Color fundus photograph; 2352x1568px; FOV: 45 degrees: 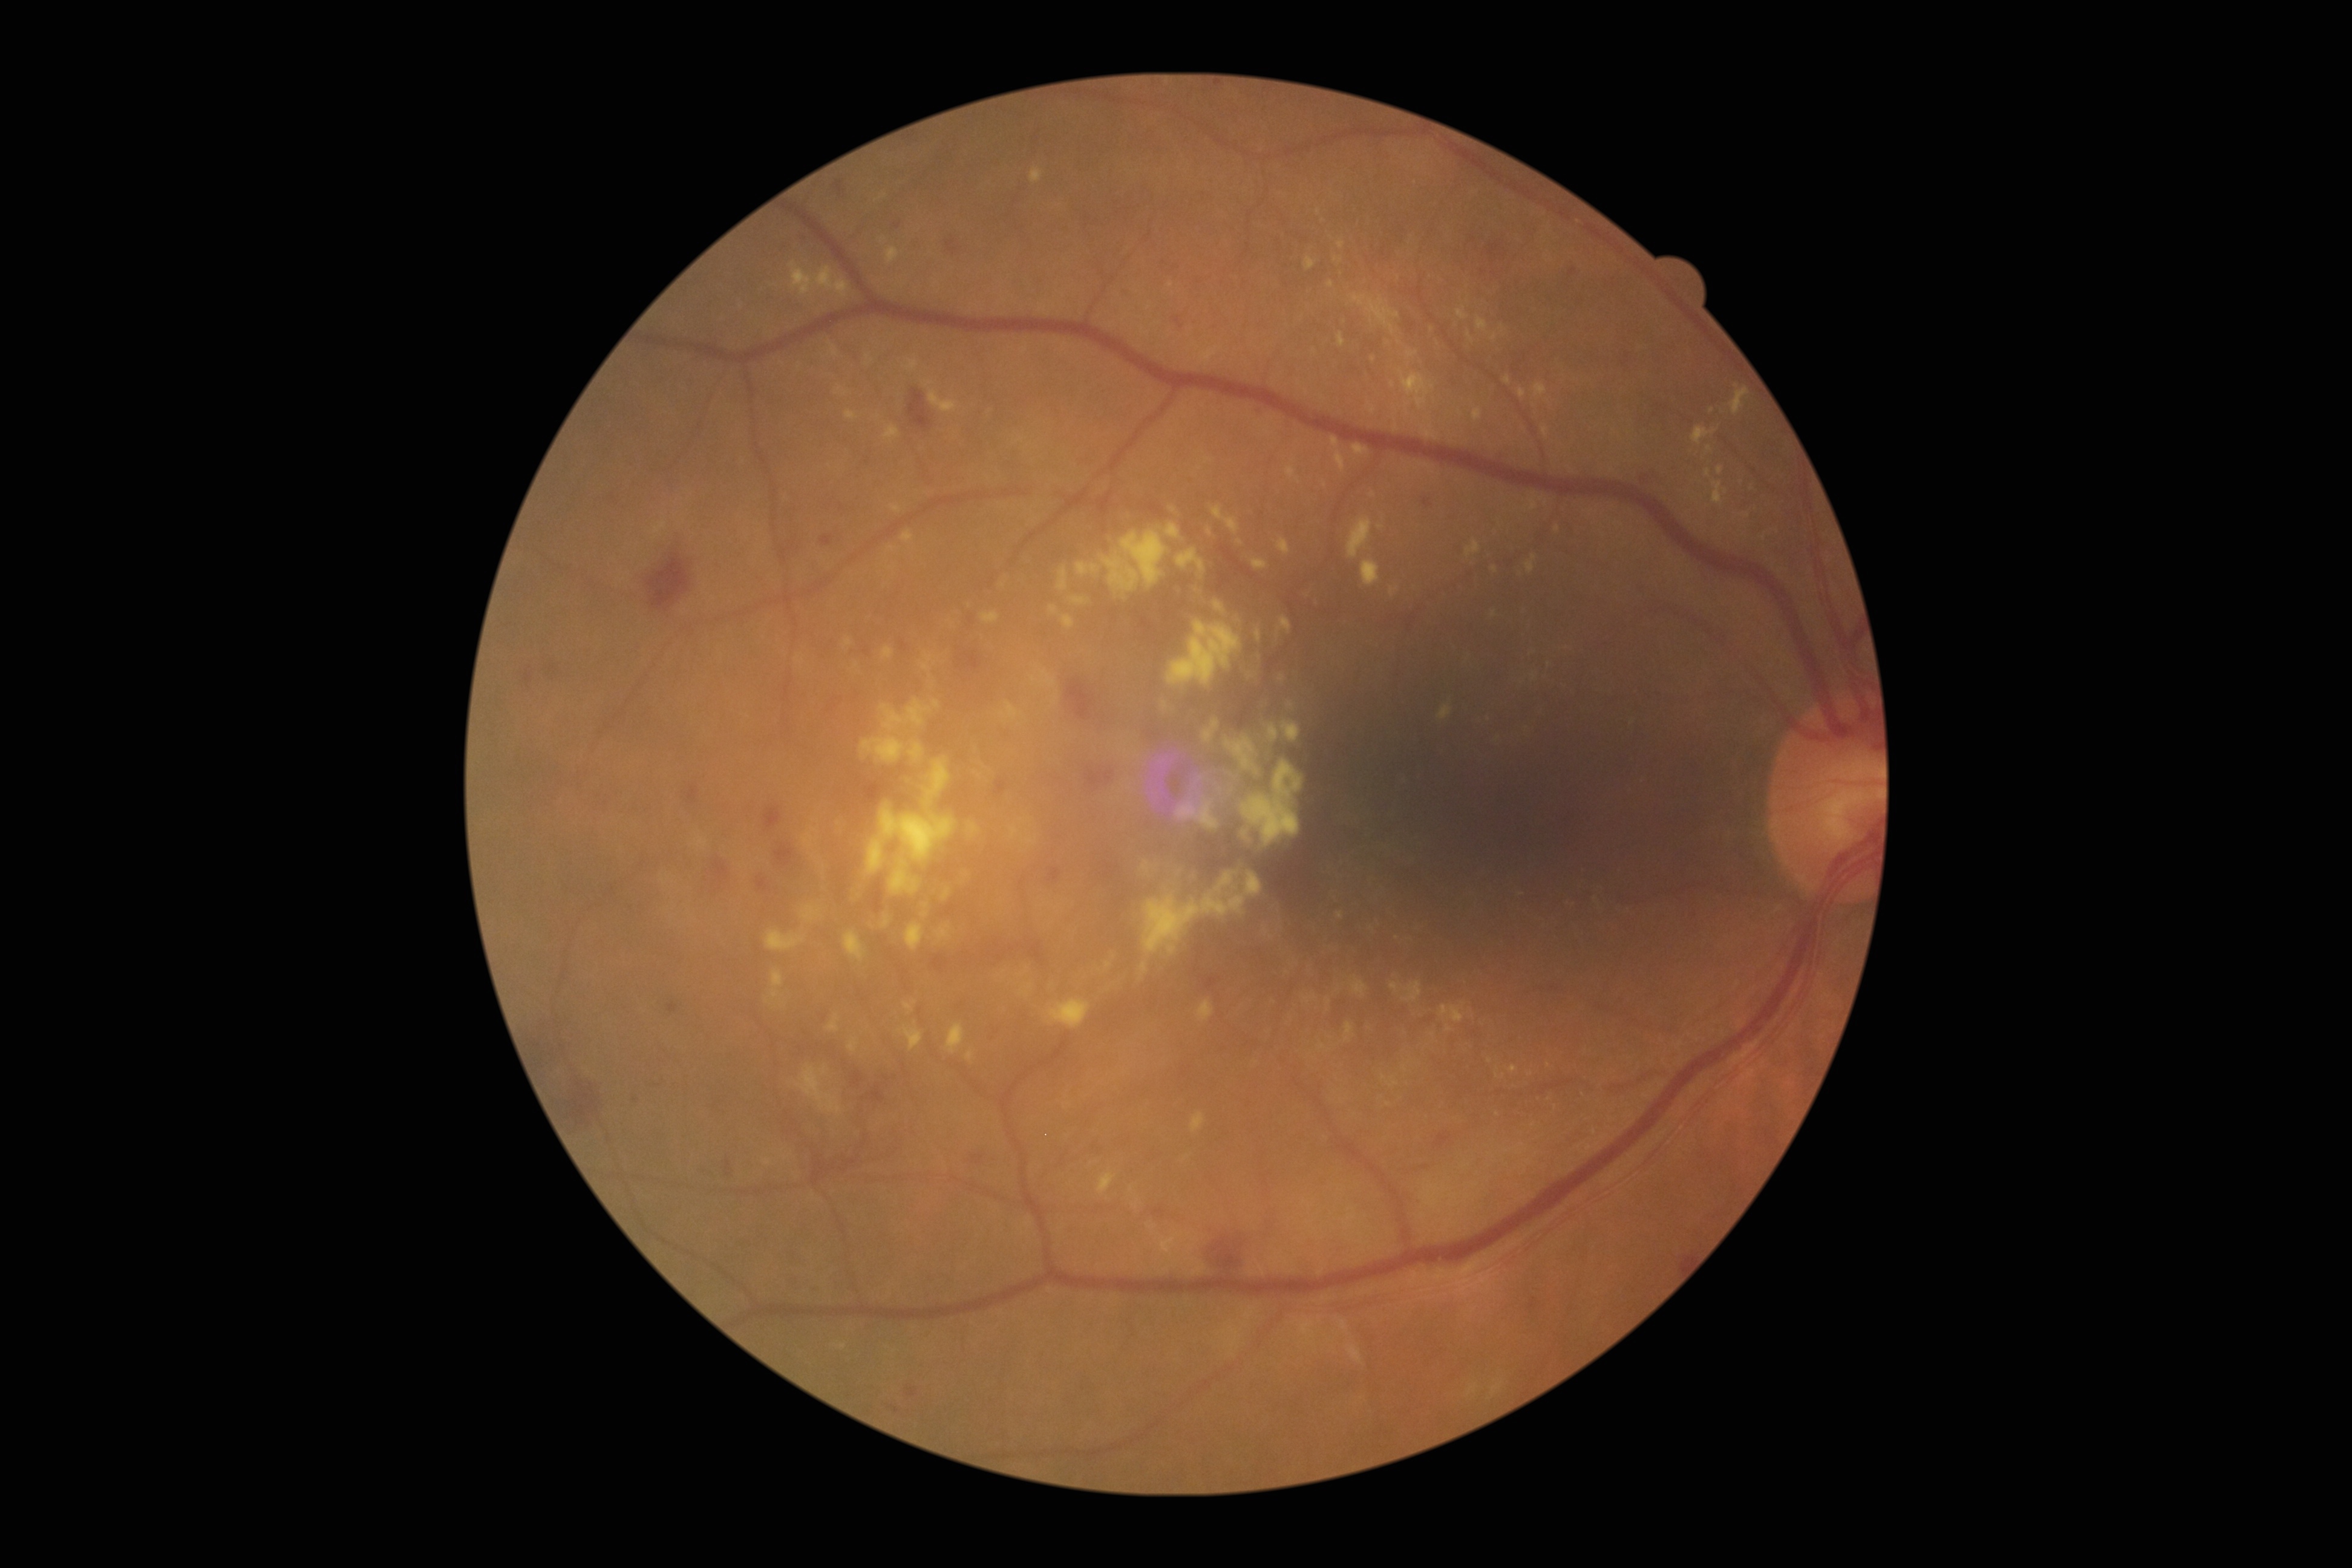
diabetic retinopathy (DR)=grade 2 — more than just microaneurysms but less than severe NPDR.